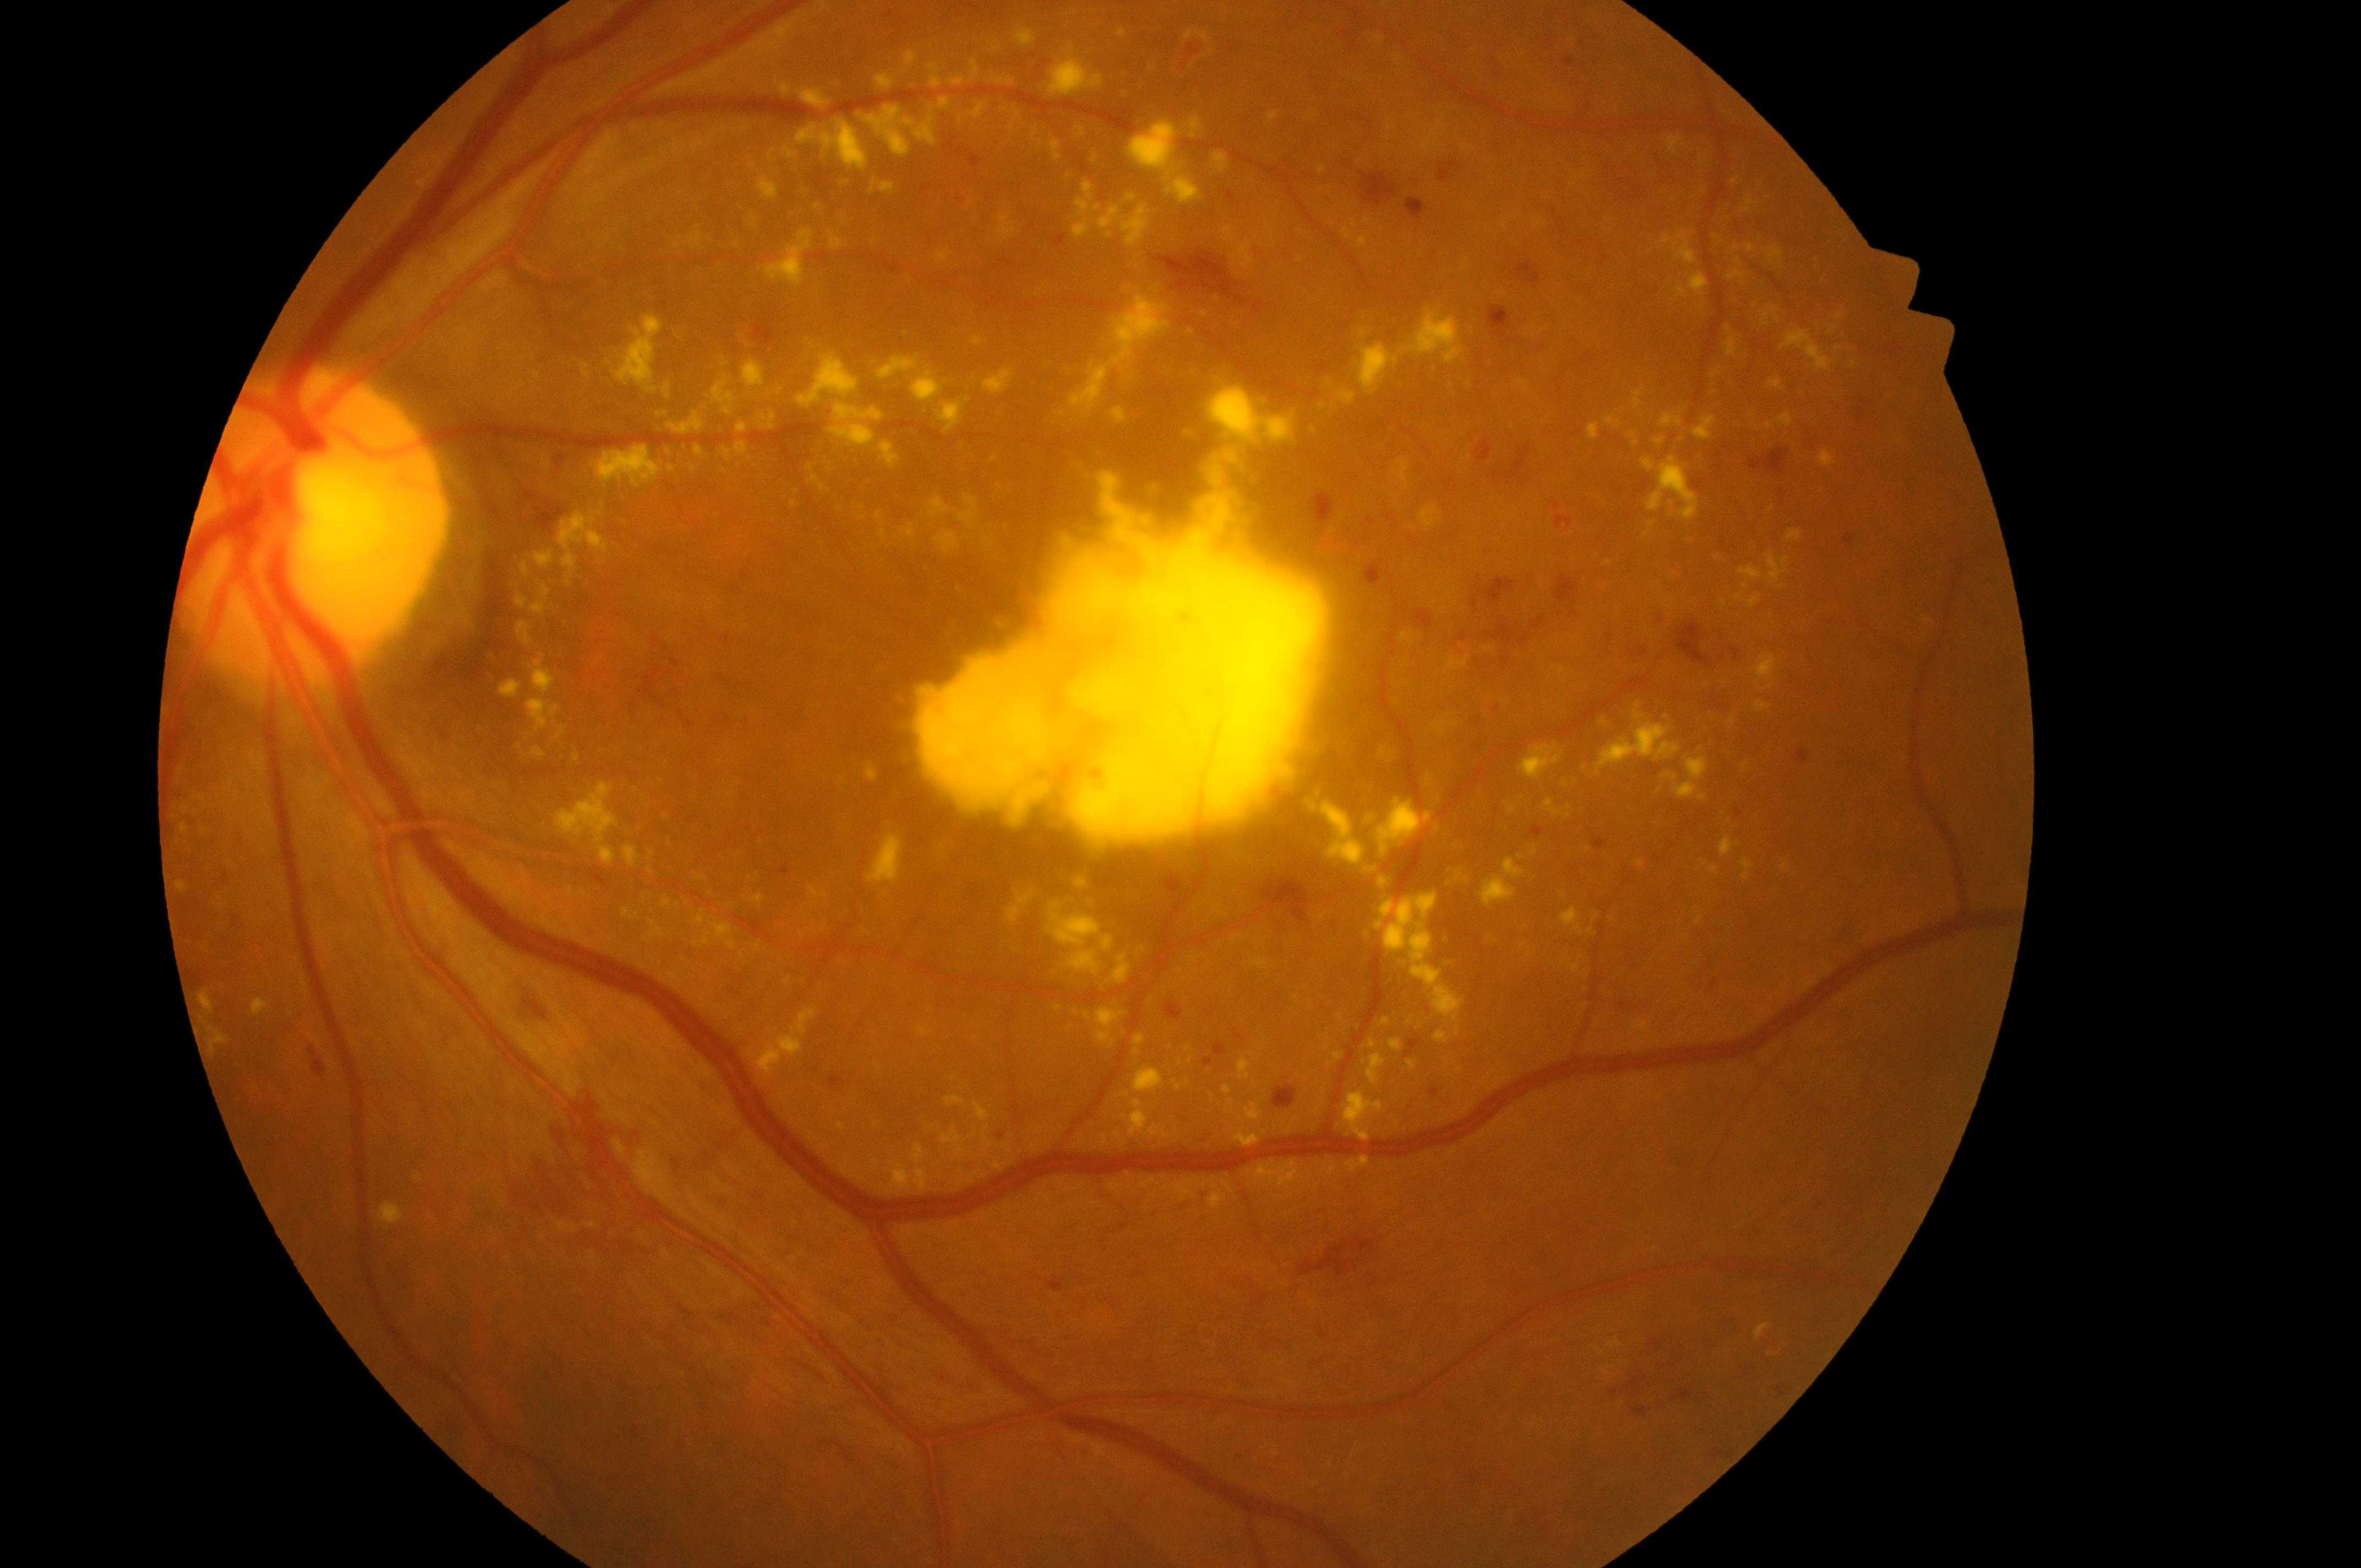

This is the oculus sinister.
DME is grade 2.
Optic disc: (289, 542).
DR stage: 4.
The macular center is at (1101, 647).